FOV: 45 degrees. Color fundus image — 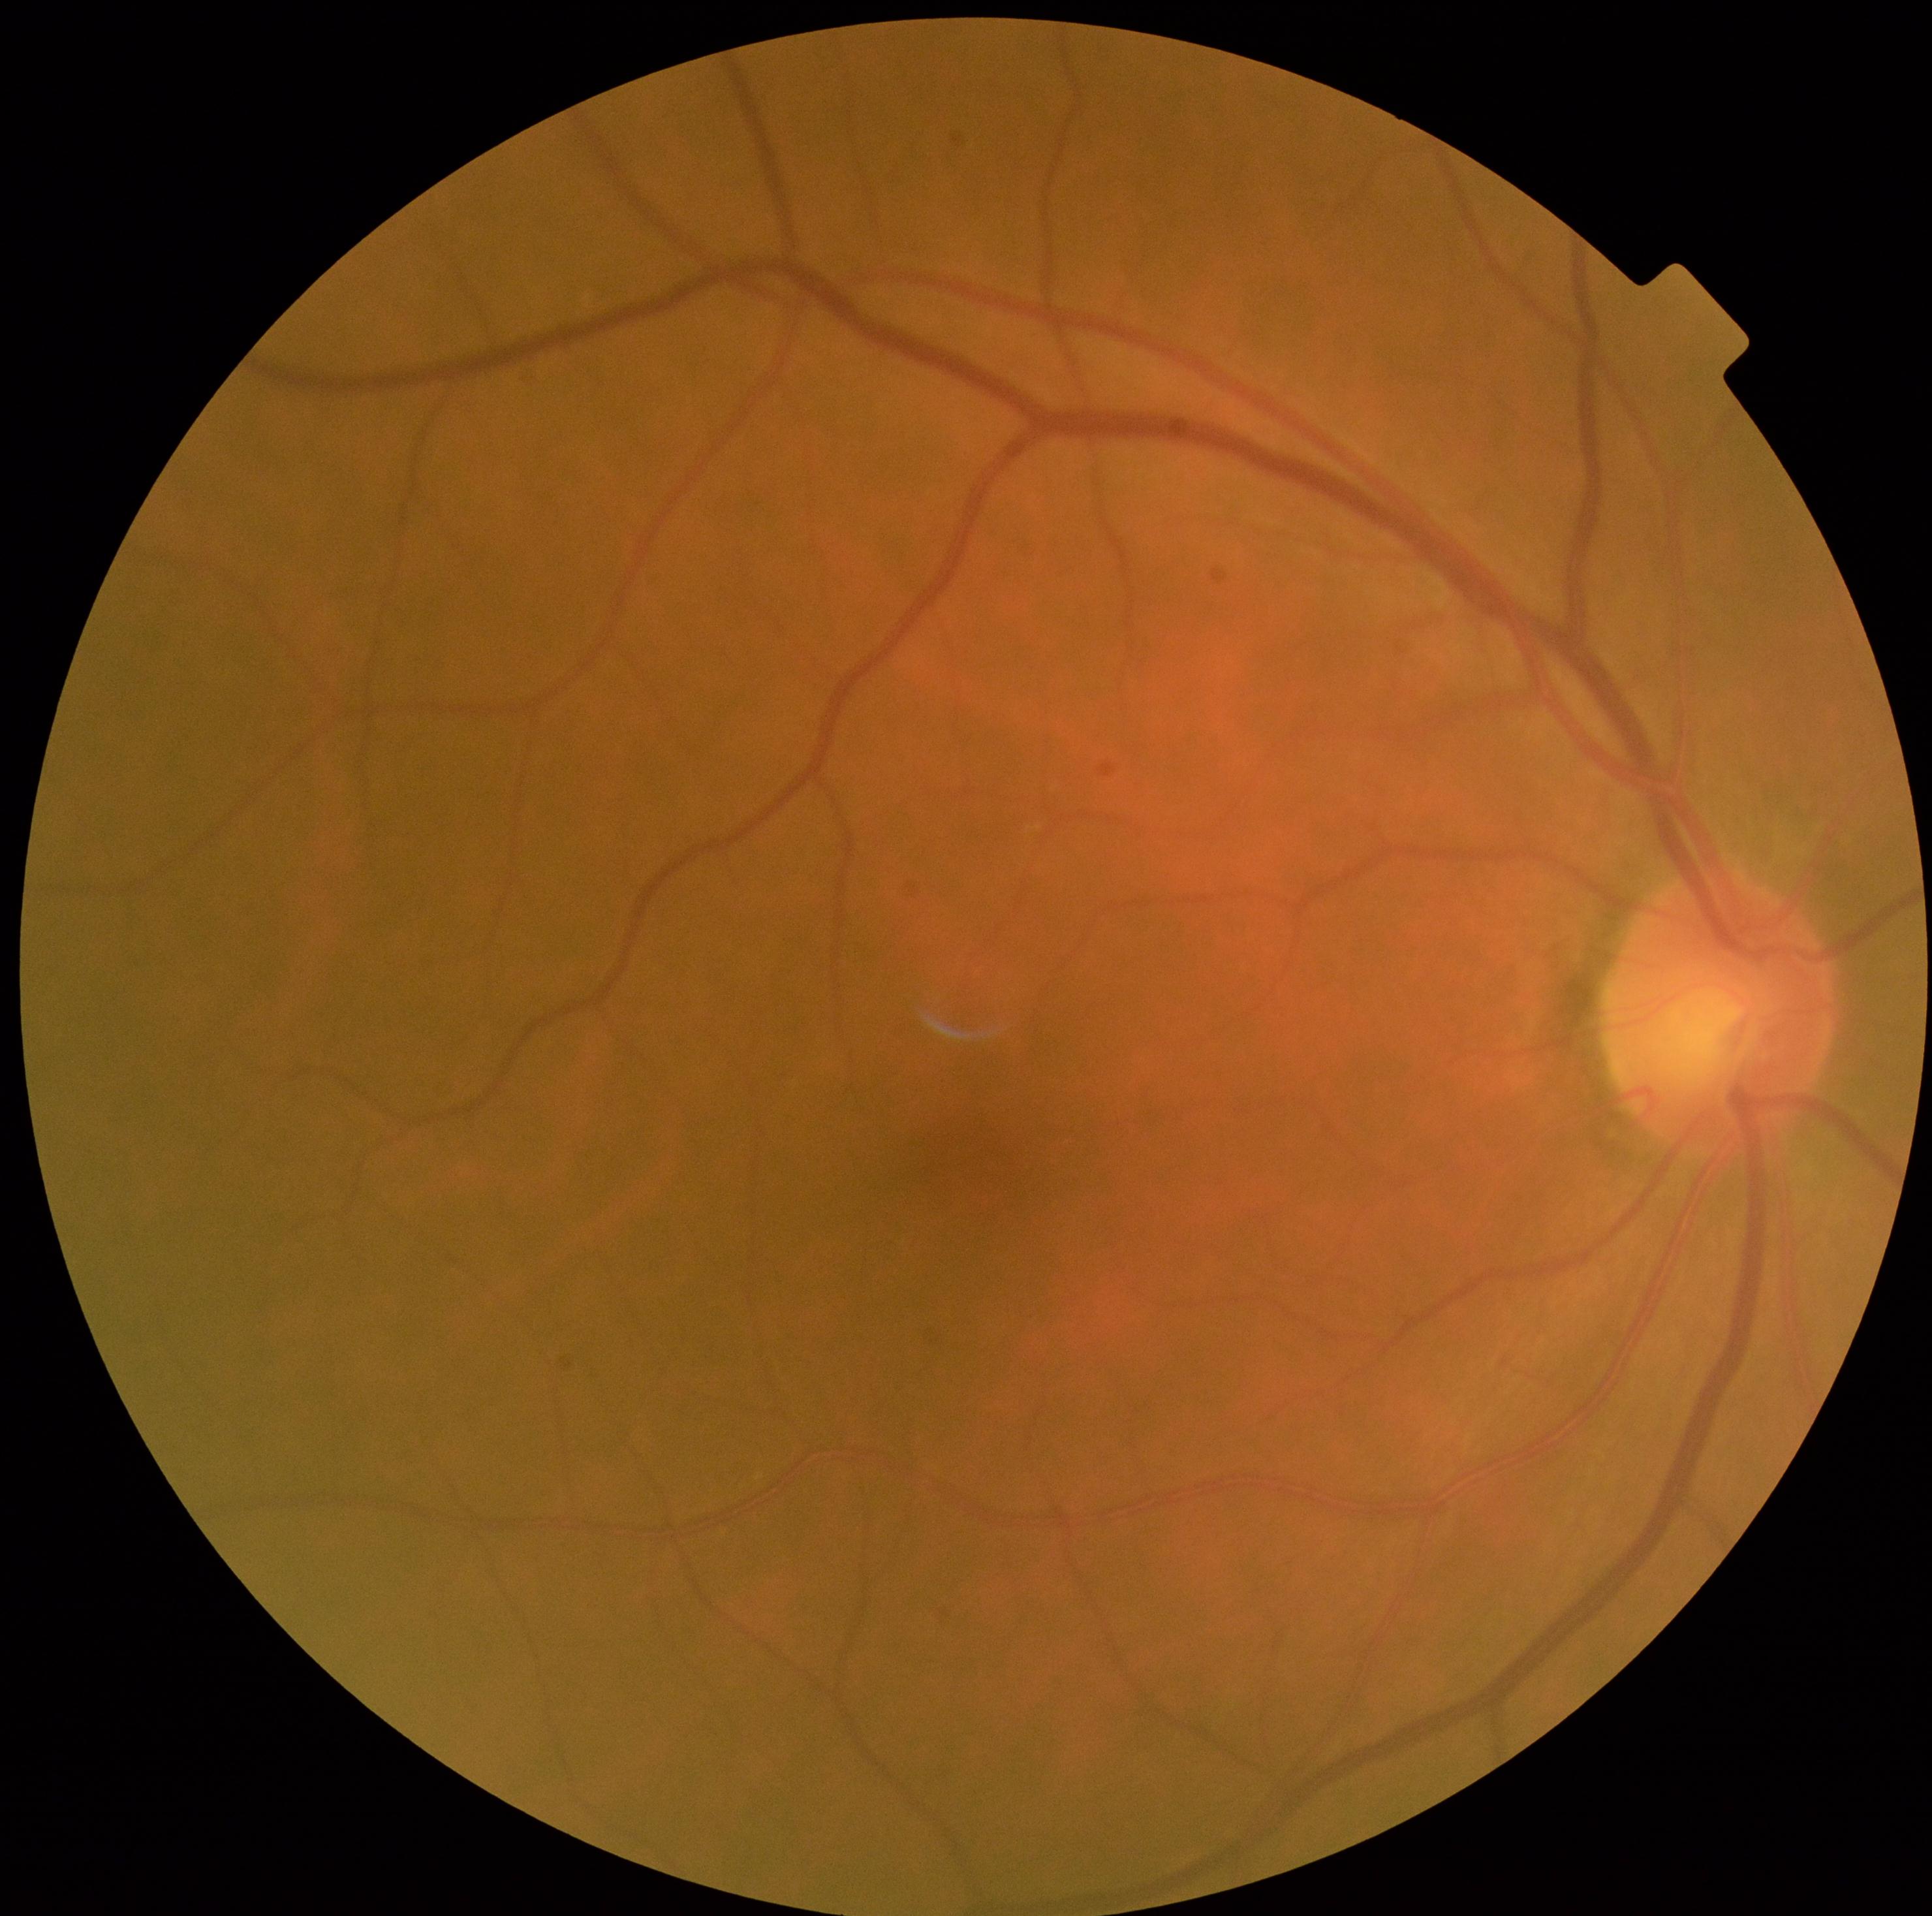 No apparent diabetic retinopathy.
DR is 0.